45° field of view; DR severity per modified Davis staging: 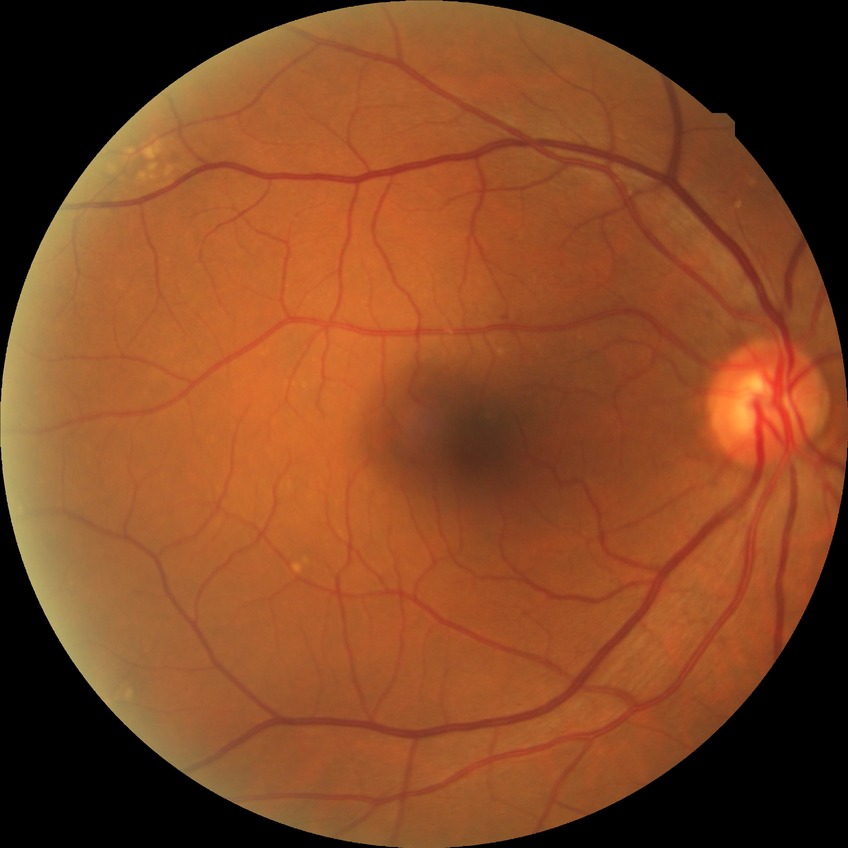
- Davis grading: no diabetic retinopathy